No pharmacologic dilation, acquired with a NIDEK AFC-230, 848x848px, 45° FOV.
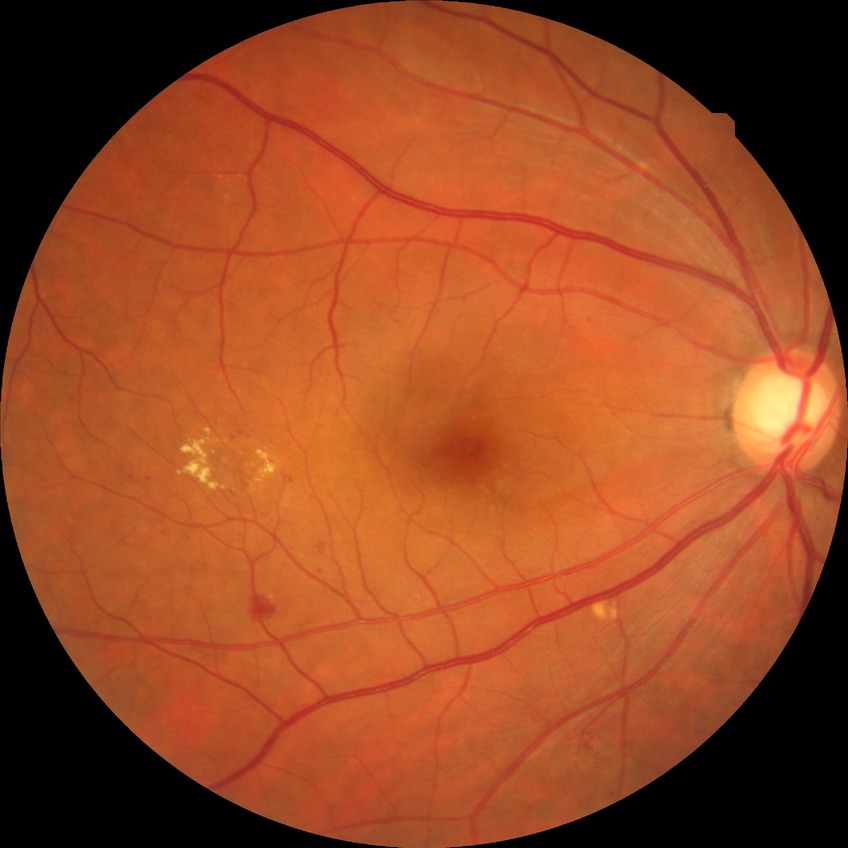
Annotations:
• diabetic retinopathy (DR): simple diabetic retinopathy (SDR)